Captured on a Topcon TRC-50DX fundus camera — 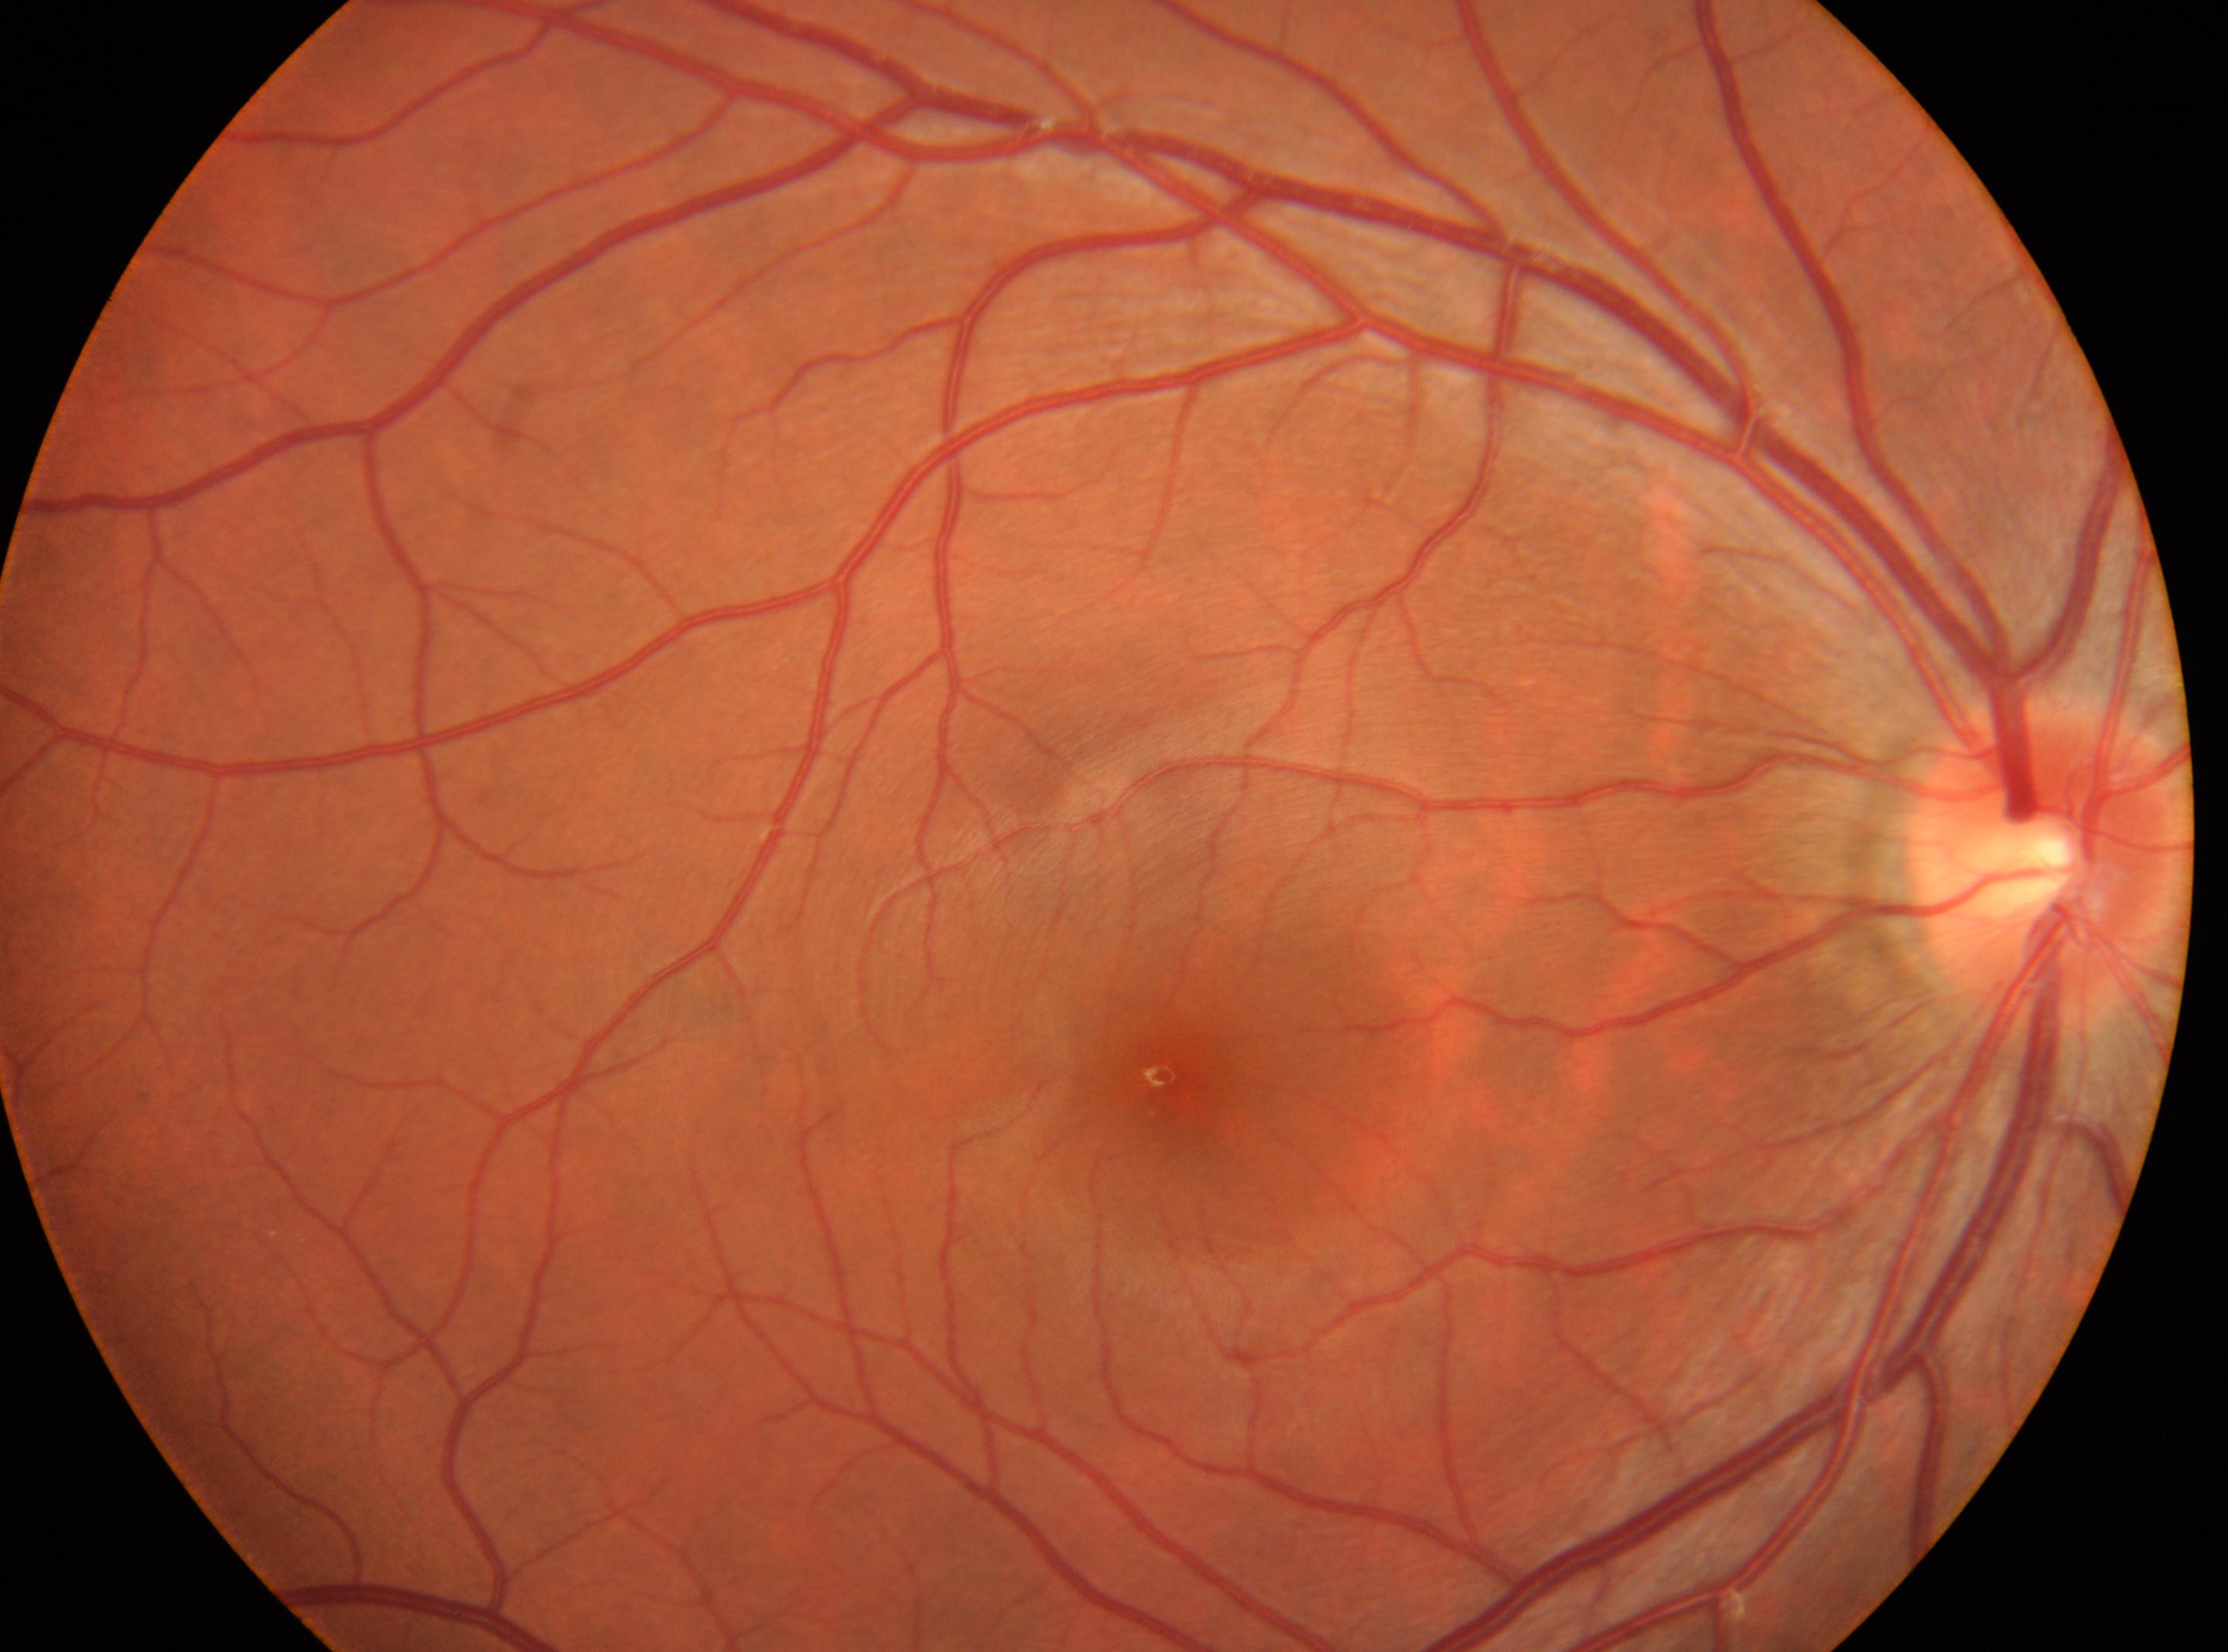

Annotations:
– DR stage: grade 0 (no apparent retinopathy)
– macular center: [1159, 1075]
– laterality: oculus dexter
– disc center: [2049, 866]